640 by 480 pixels · camera: Clarity RetCam 3 (130° FOV) · RetCam wide-field infant fundus image:
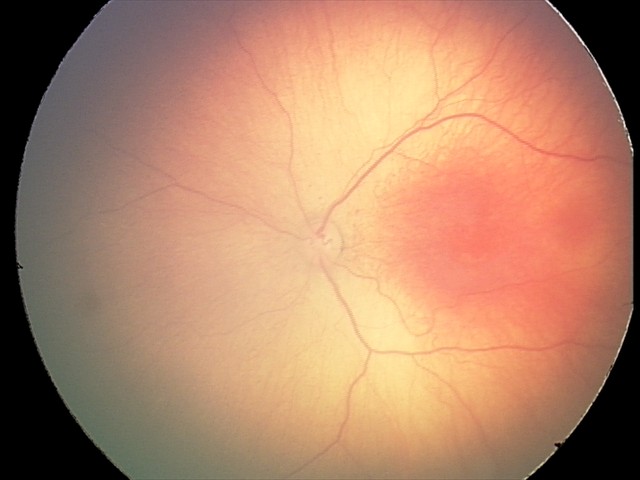
Series diagnosed as ROP stage 2.